Disc-centered field — 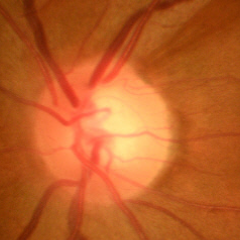

Glaucoma diagnosis: early glaucomatous optic neuropathy.